45° FOV
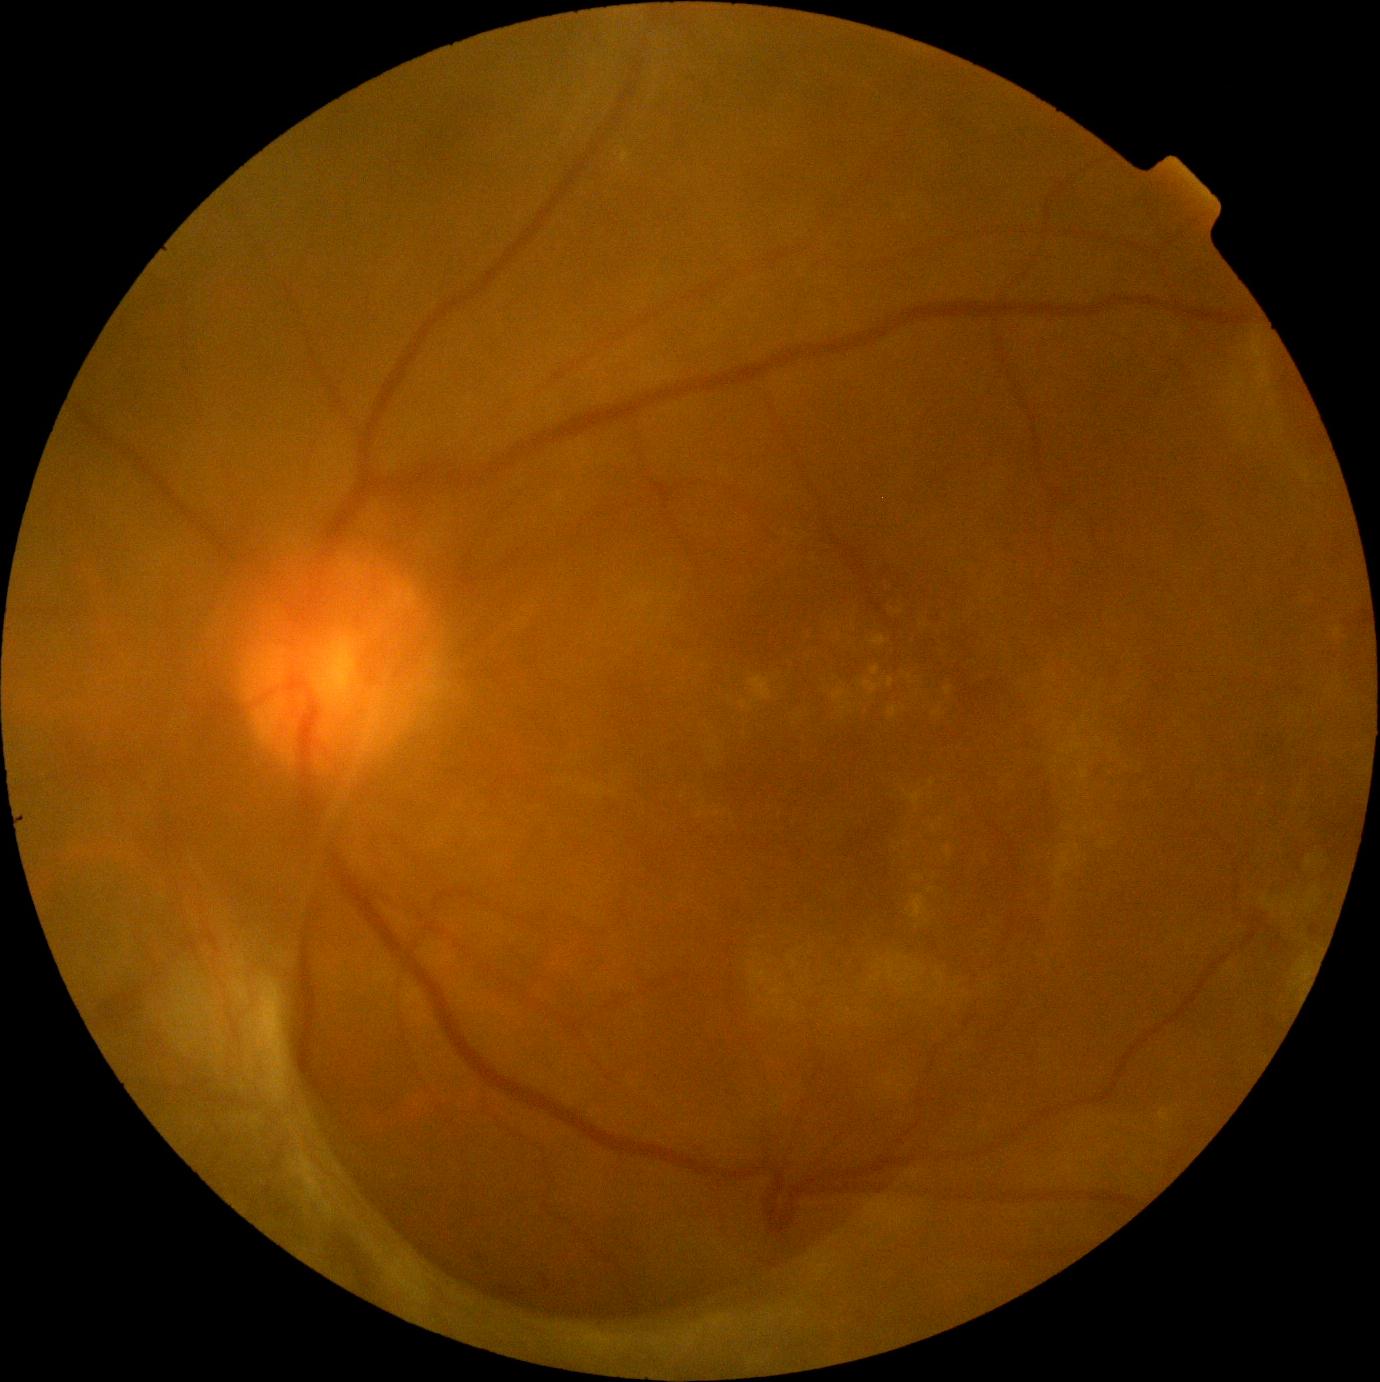
  dr_grade: 4